Pupil-dilated · field includes the optic disc and macula — 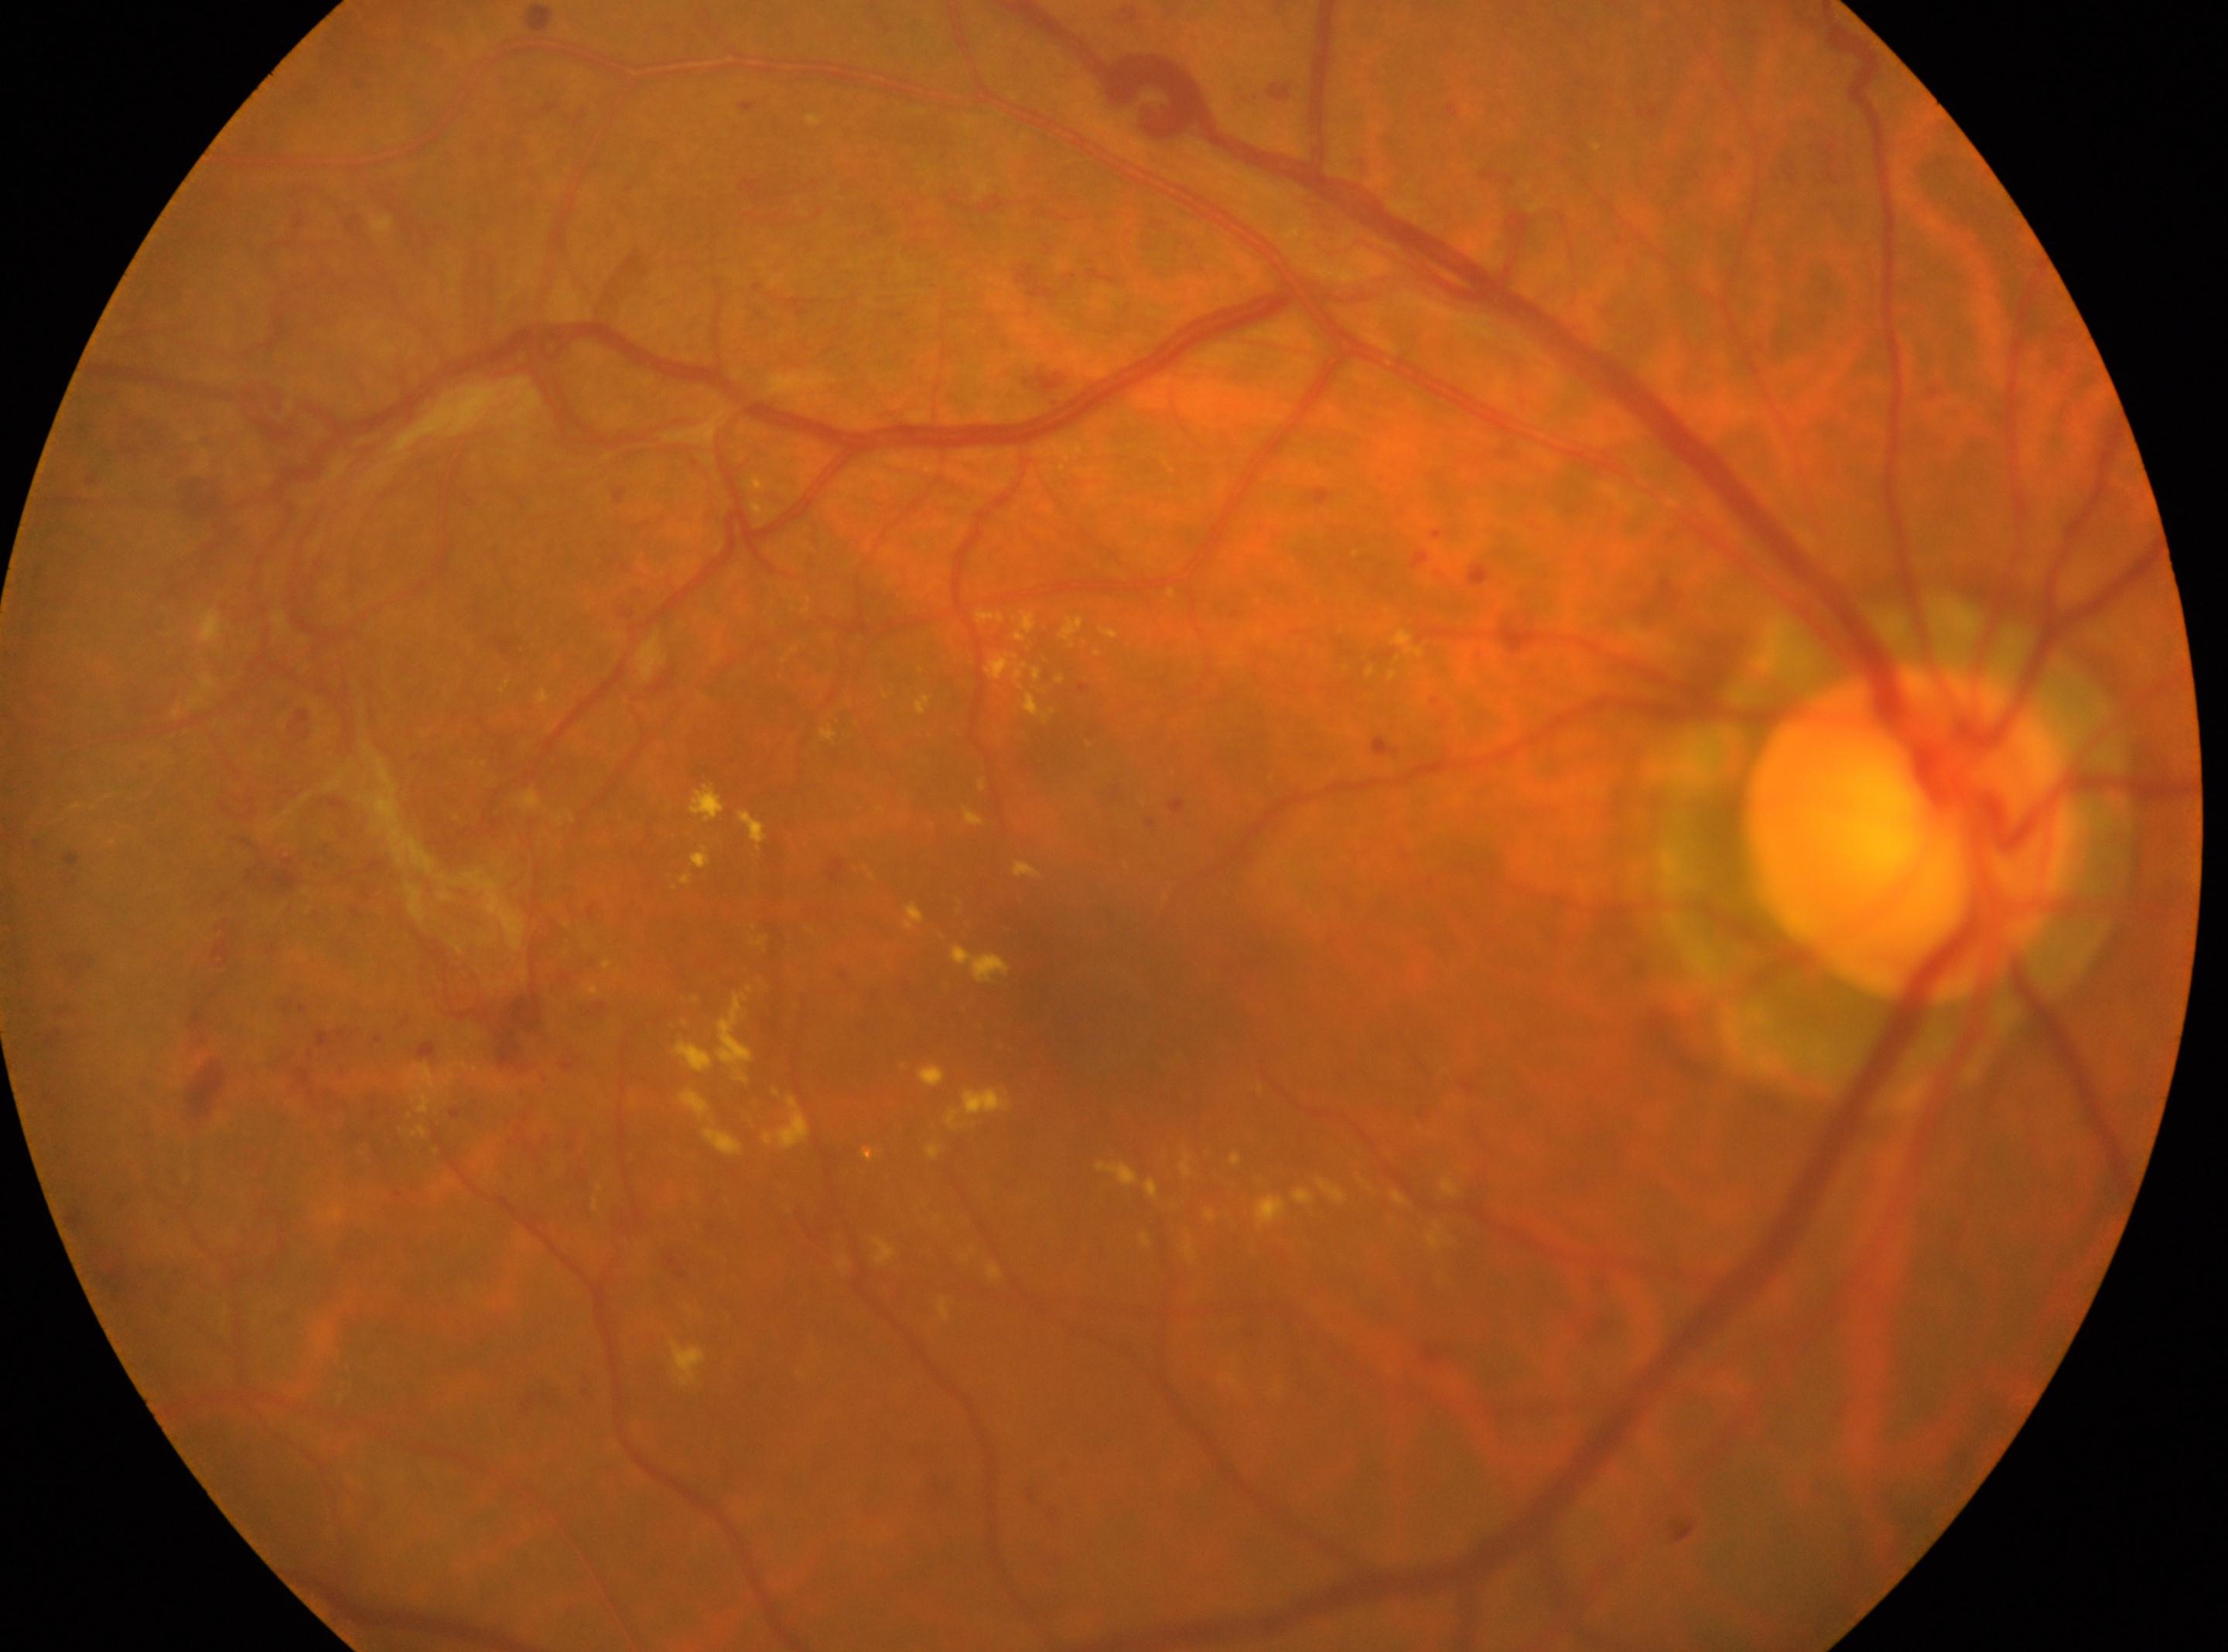

The image shows the right eye. DR stage is proliferative diabetic retinopathy (grade 4). The fovea is at [1097, 987]. The optic disc is at [1909, 835].